Image size 1240x1240; wide-field contact fundus photograph of an infant.
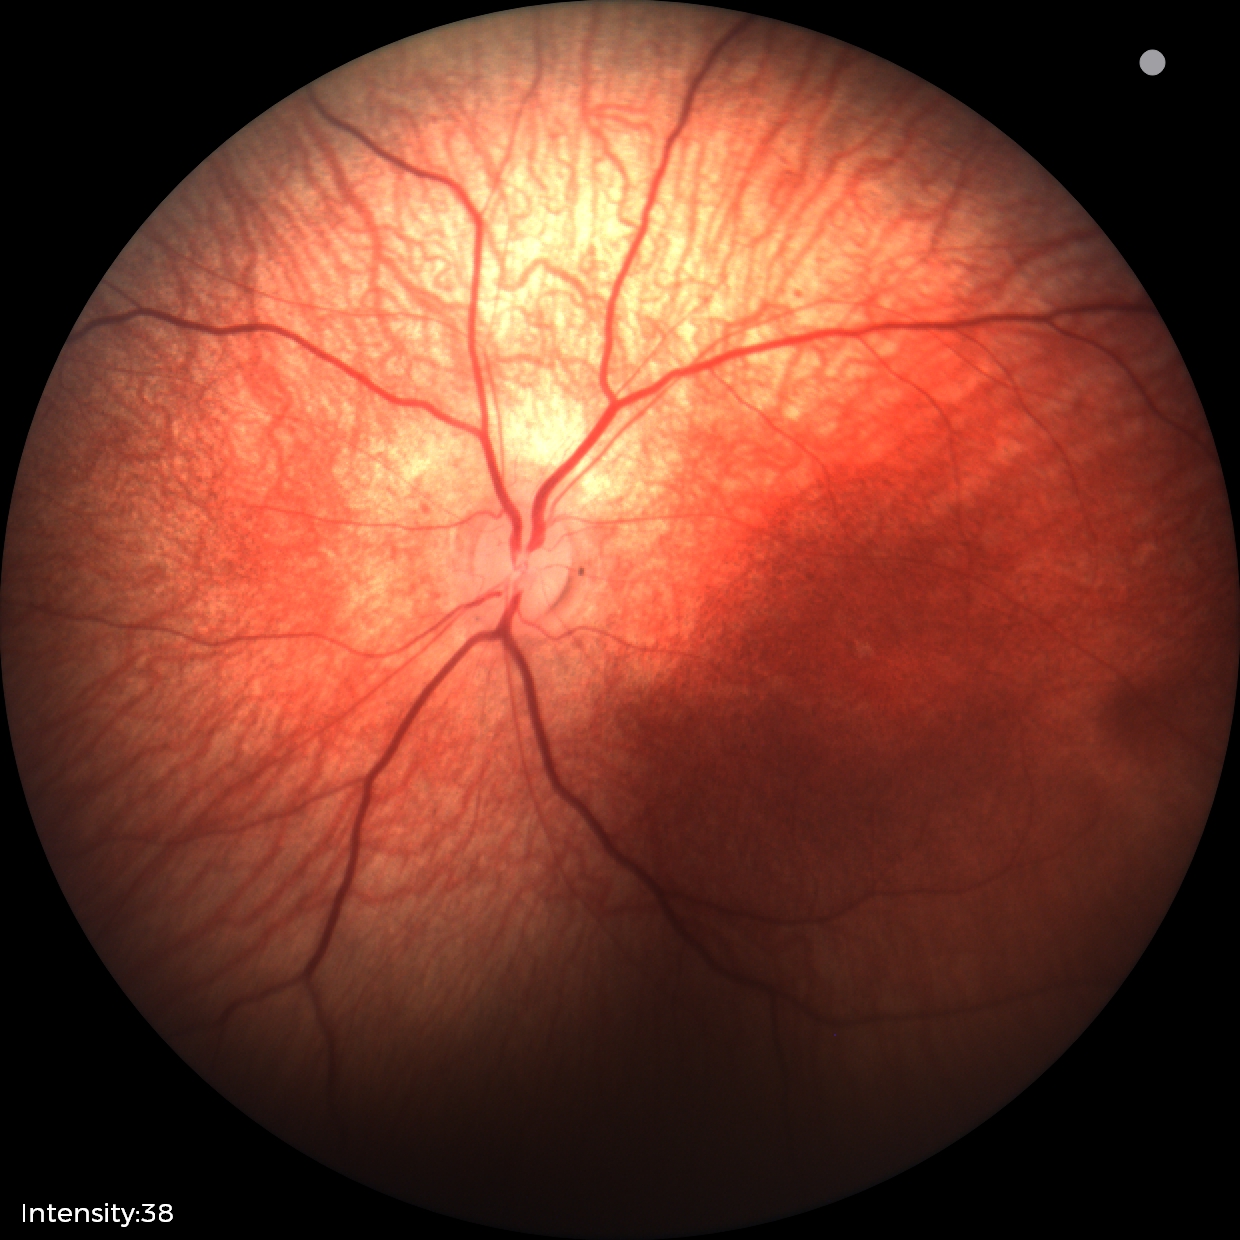
Assessment: no abnormal retinal findings.